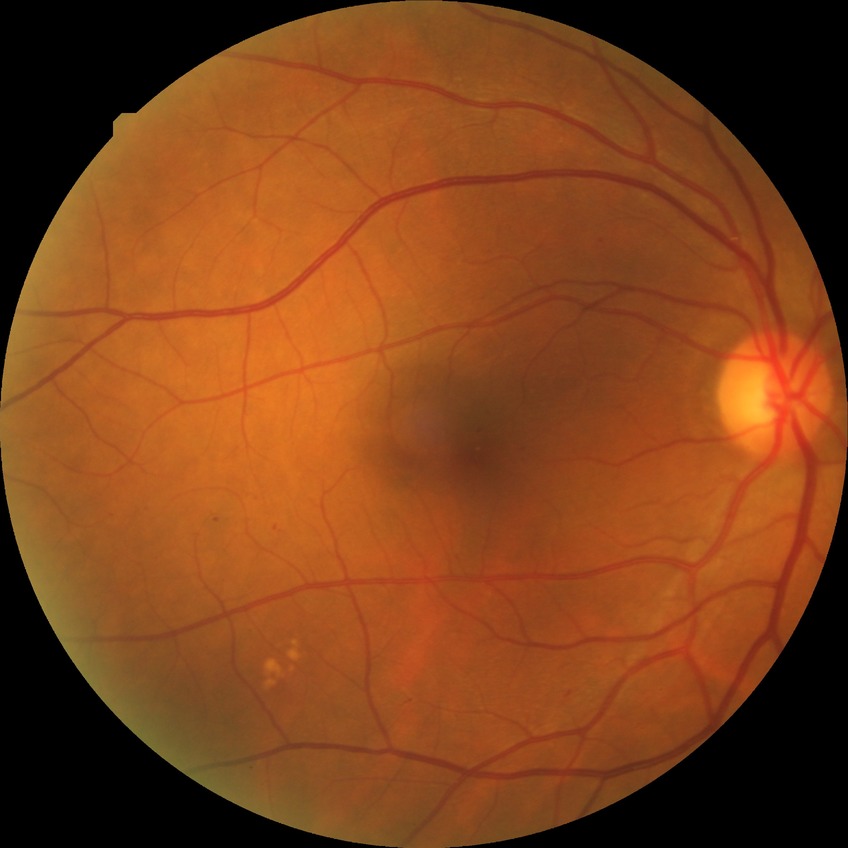 retinopathy grade: simple diabetic retinopathy.